45° FOV:
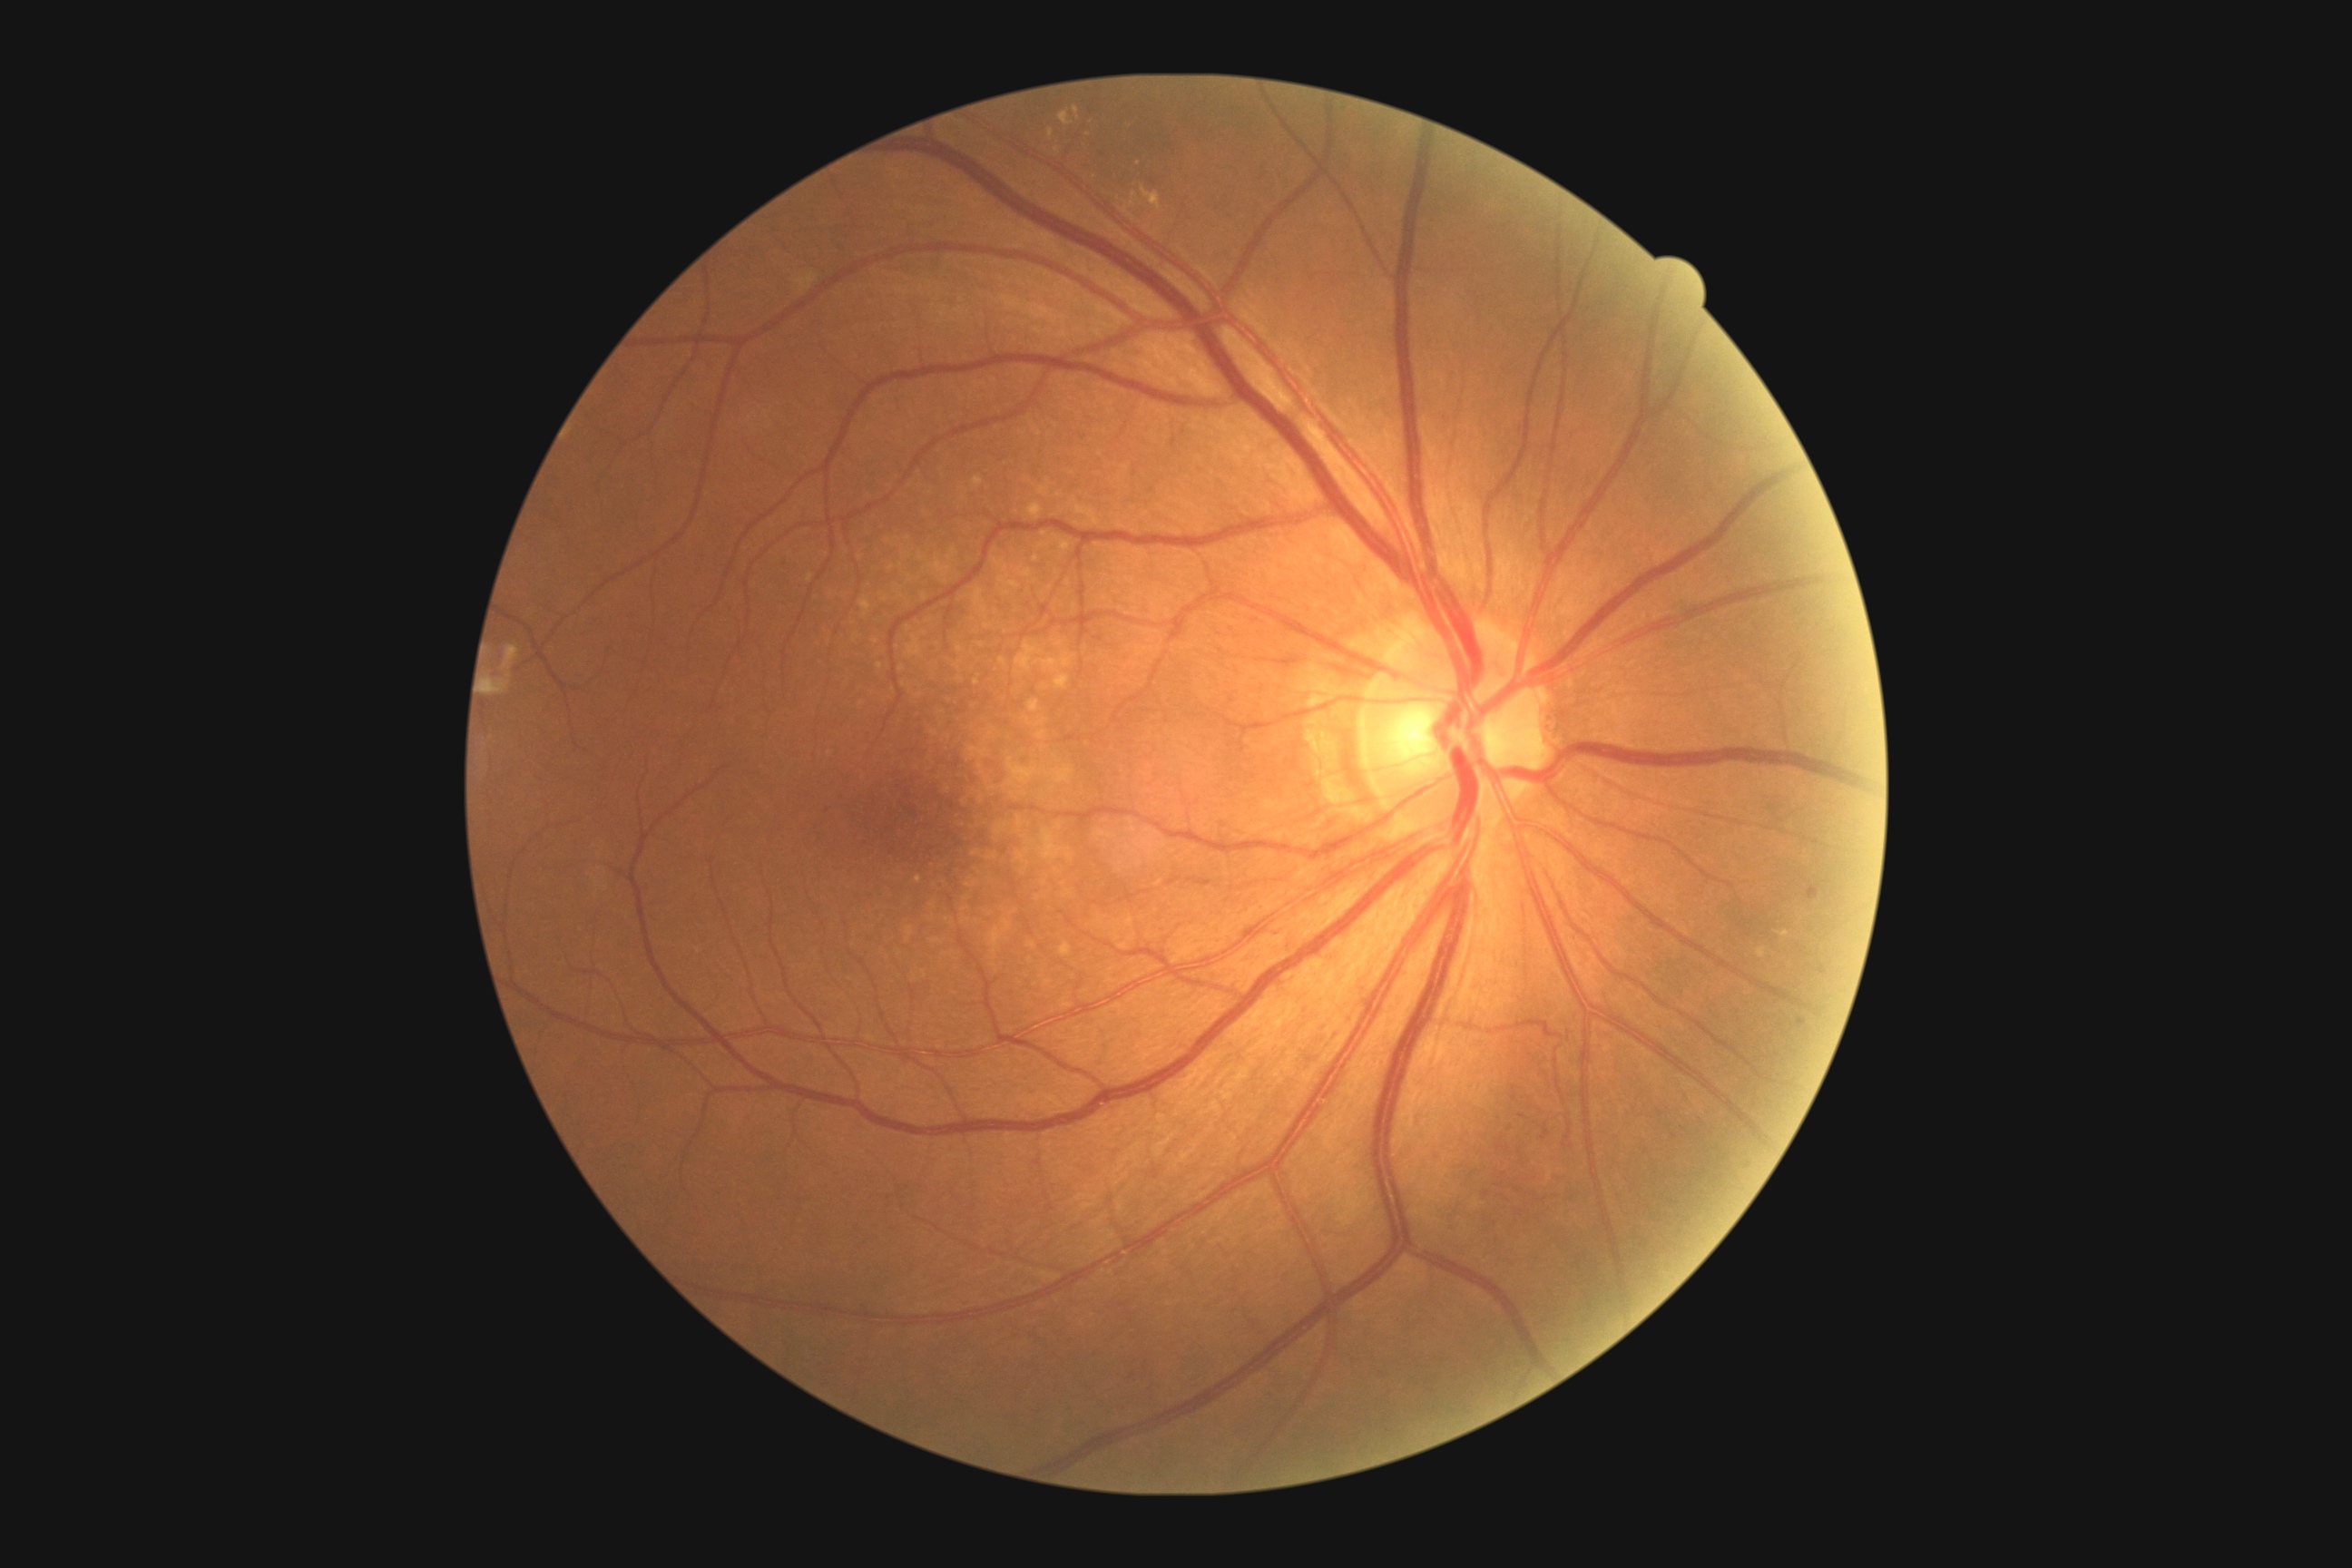 Diabetic retinopathy severity: grade 2.